Pediatric retinal photograph (wide-field). Captured with the Natus RetCam Envision (130° field of view). Image size 1440x1080 — 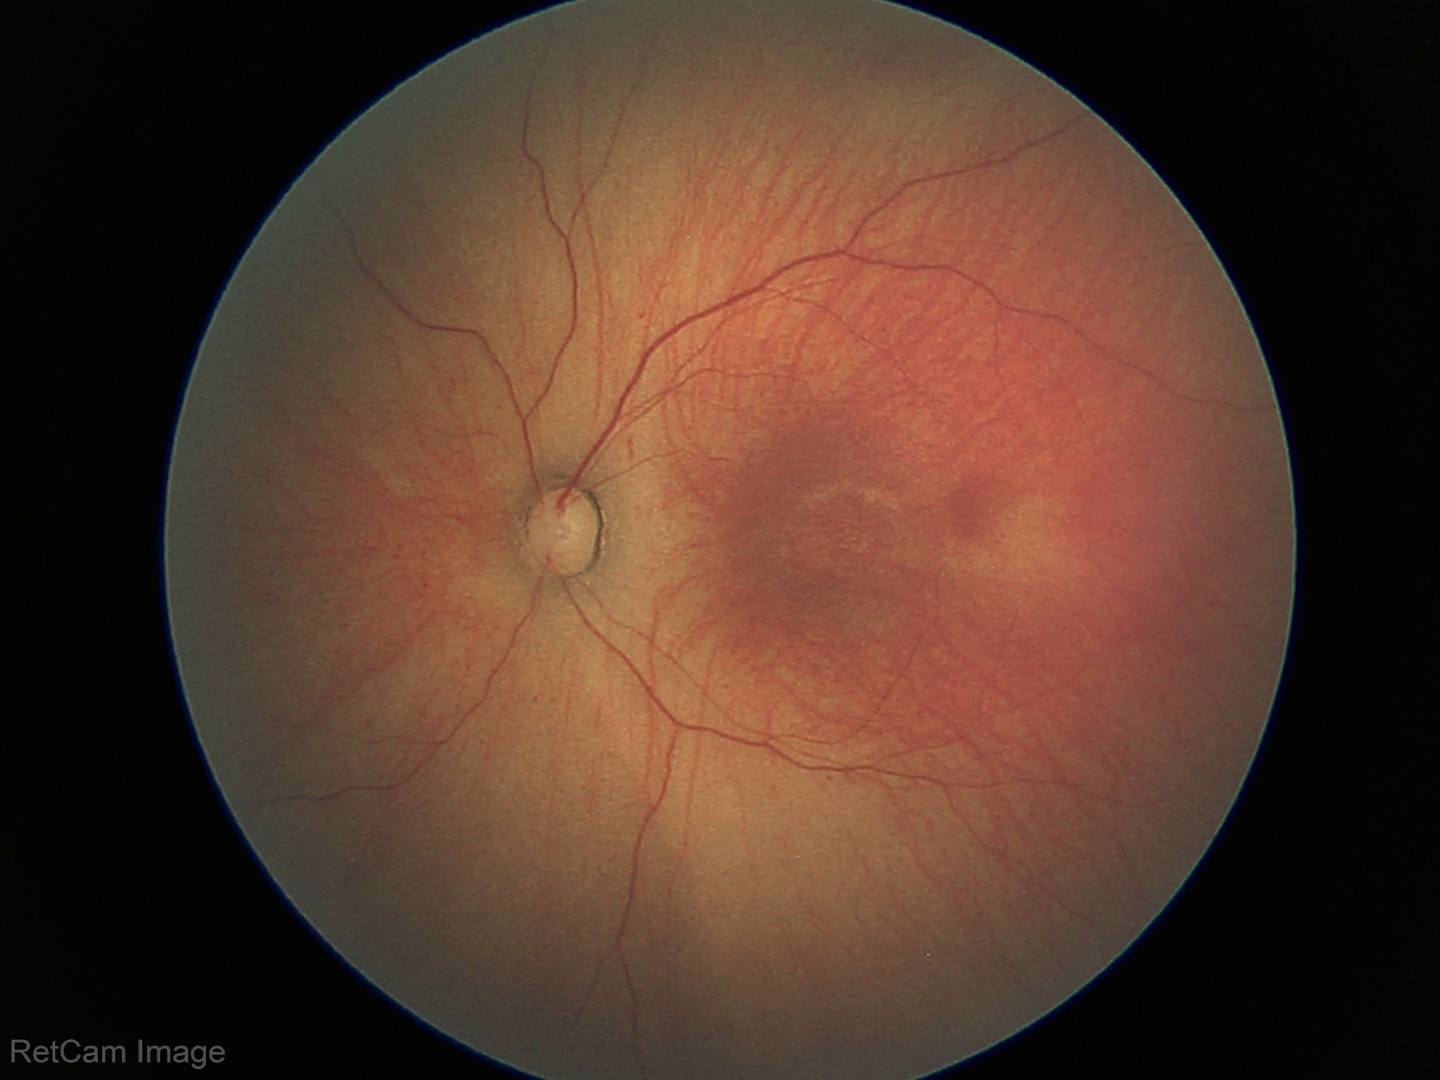

Impression: retinopathy of prematurity stage 1 — demarcation line between vascular and avascular retina | no plus disease.